2212 x 1659 pixels; 45° FOV; CFP:
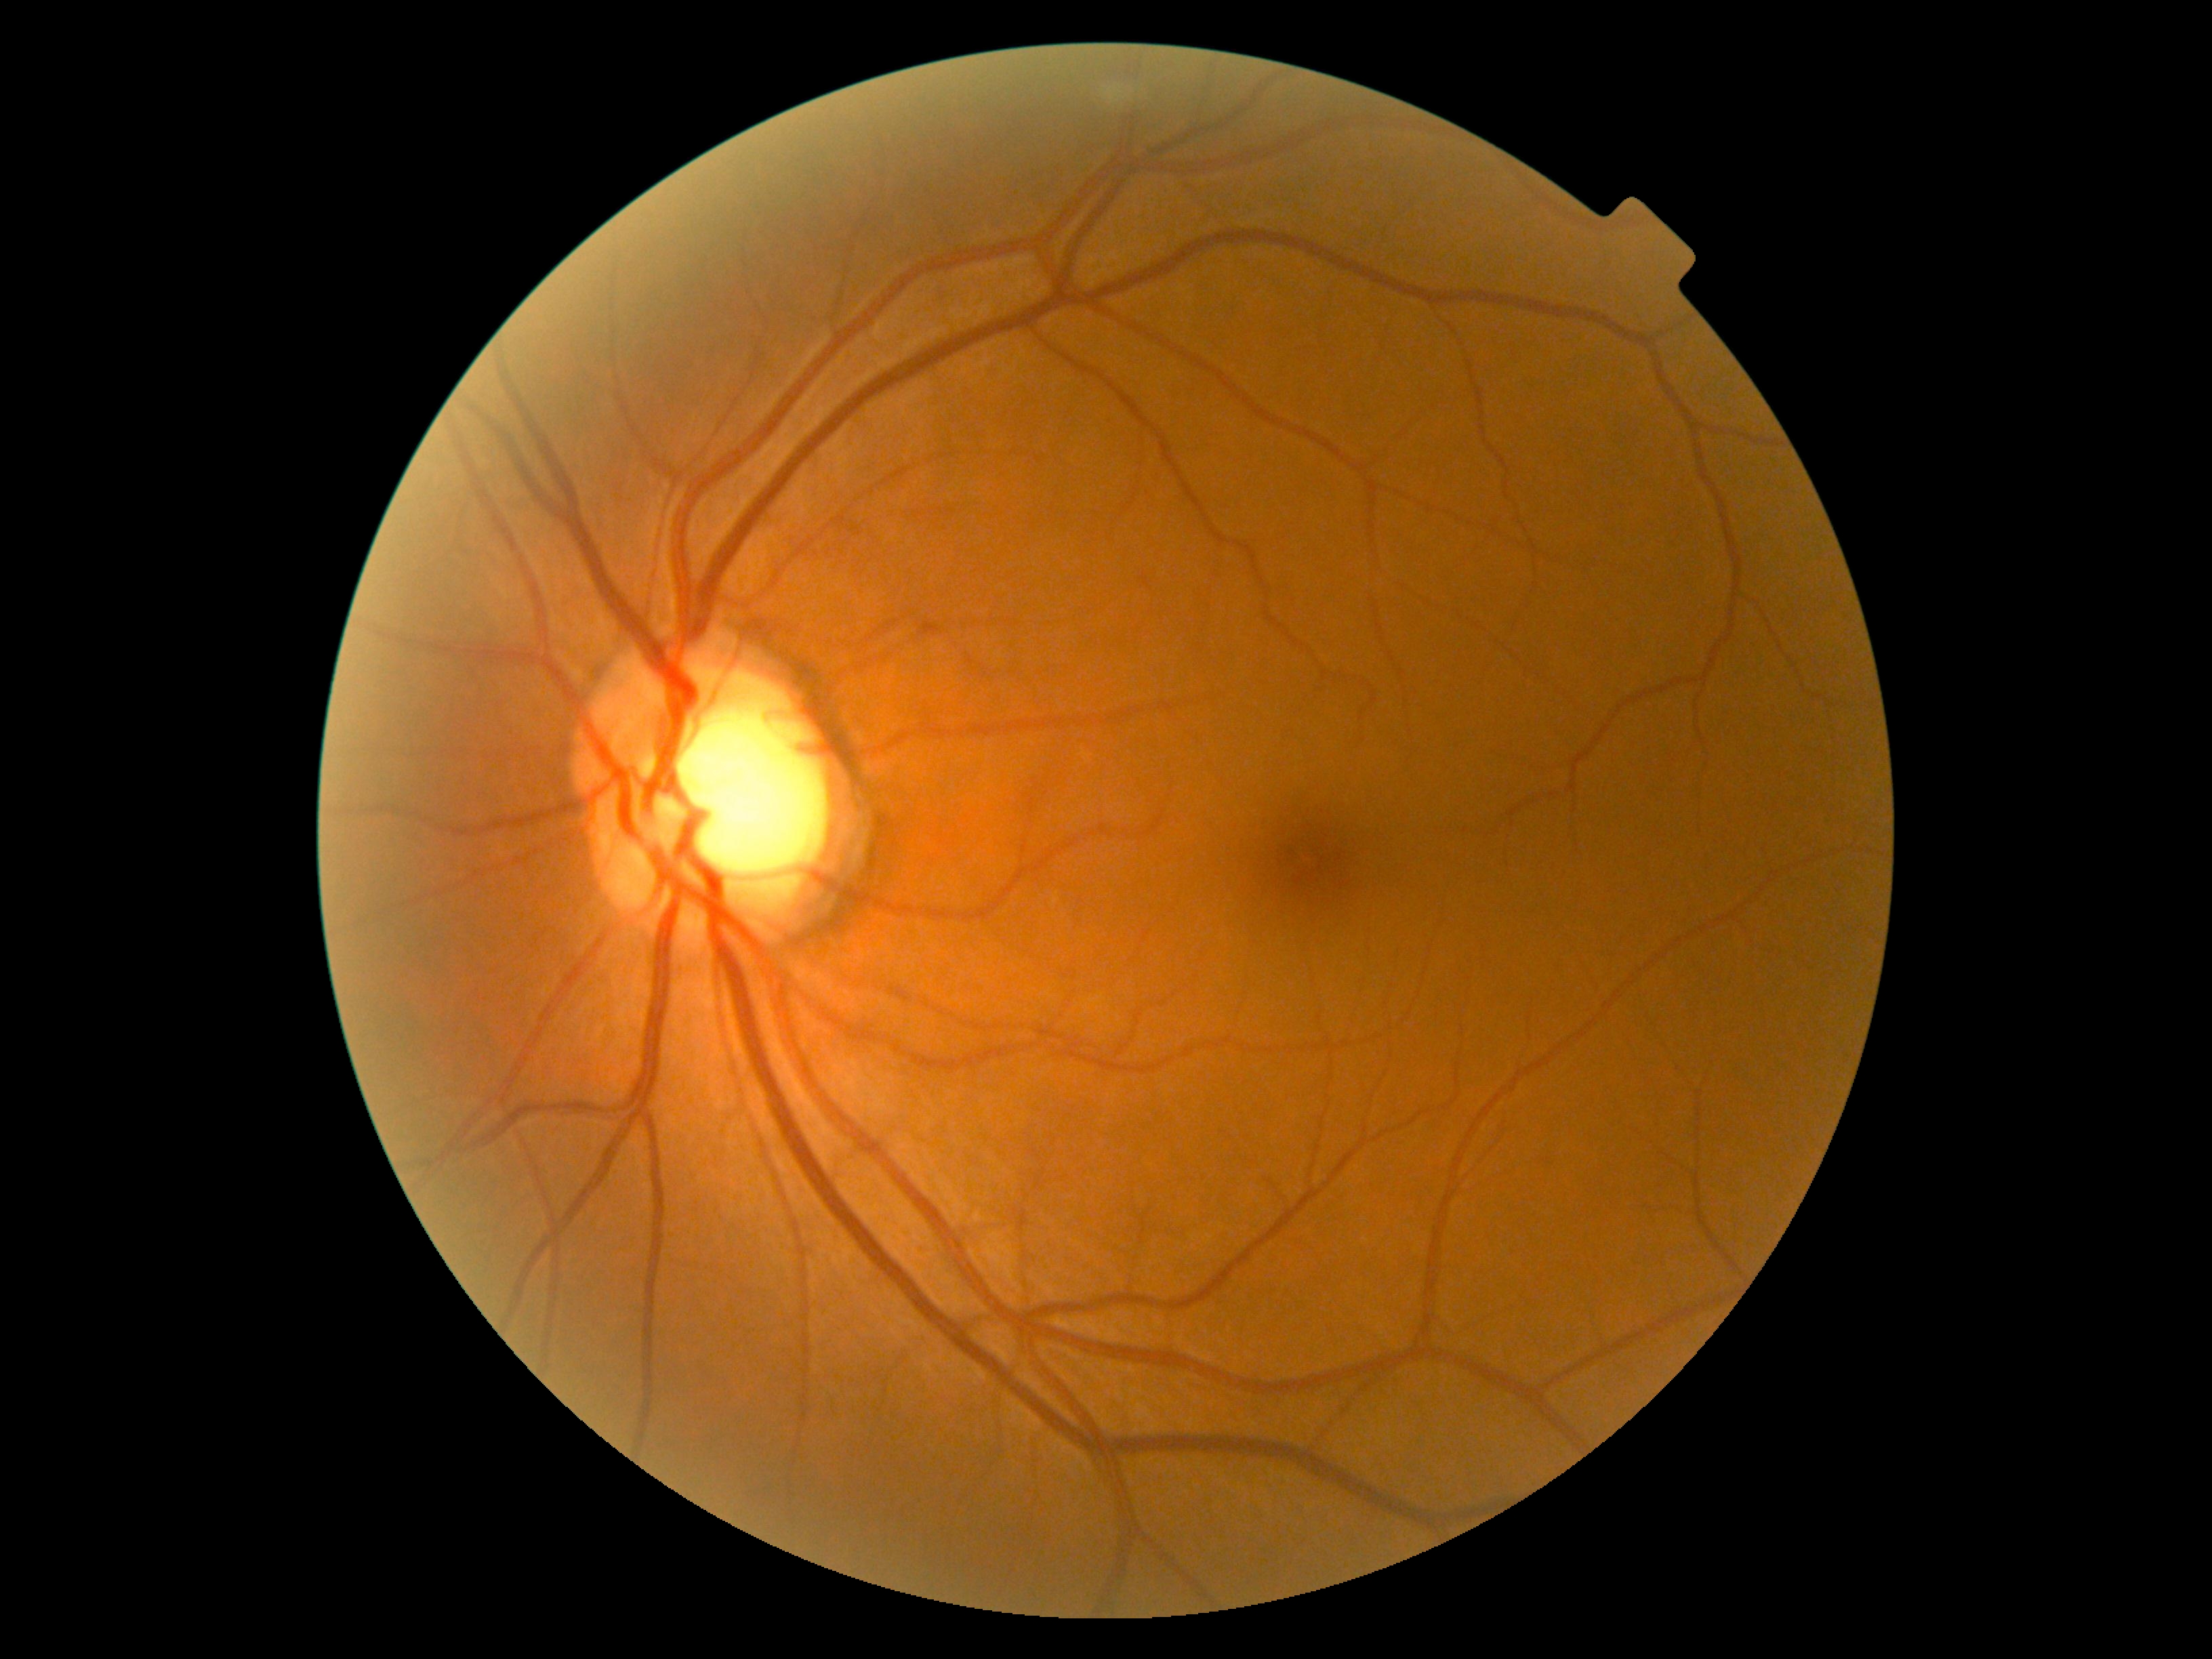
DR = no apparent retinopathy (grade 0).